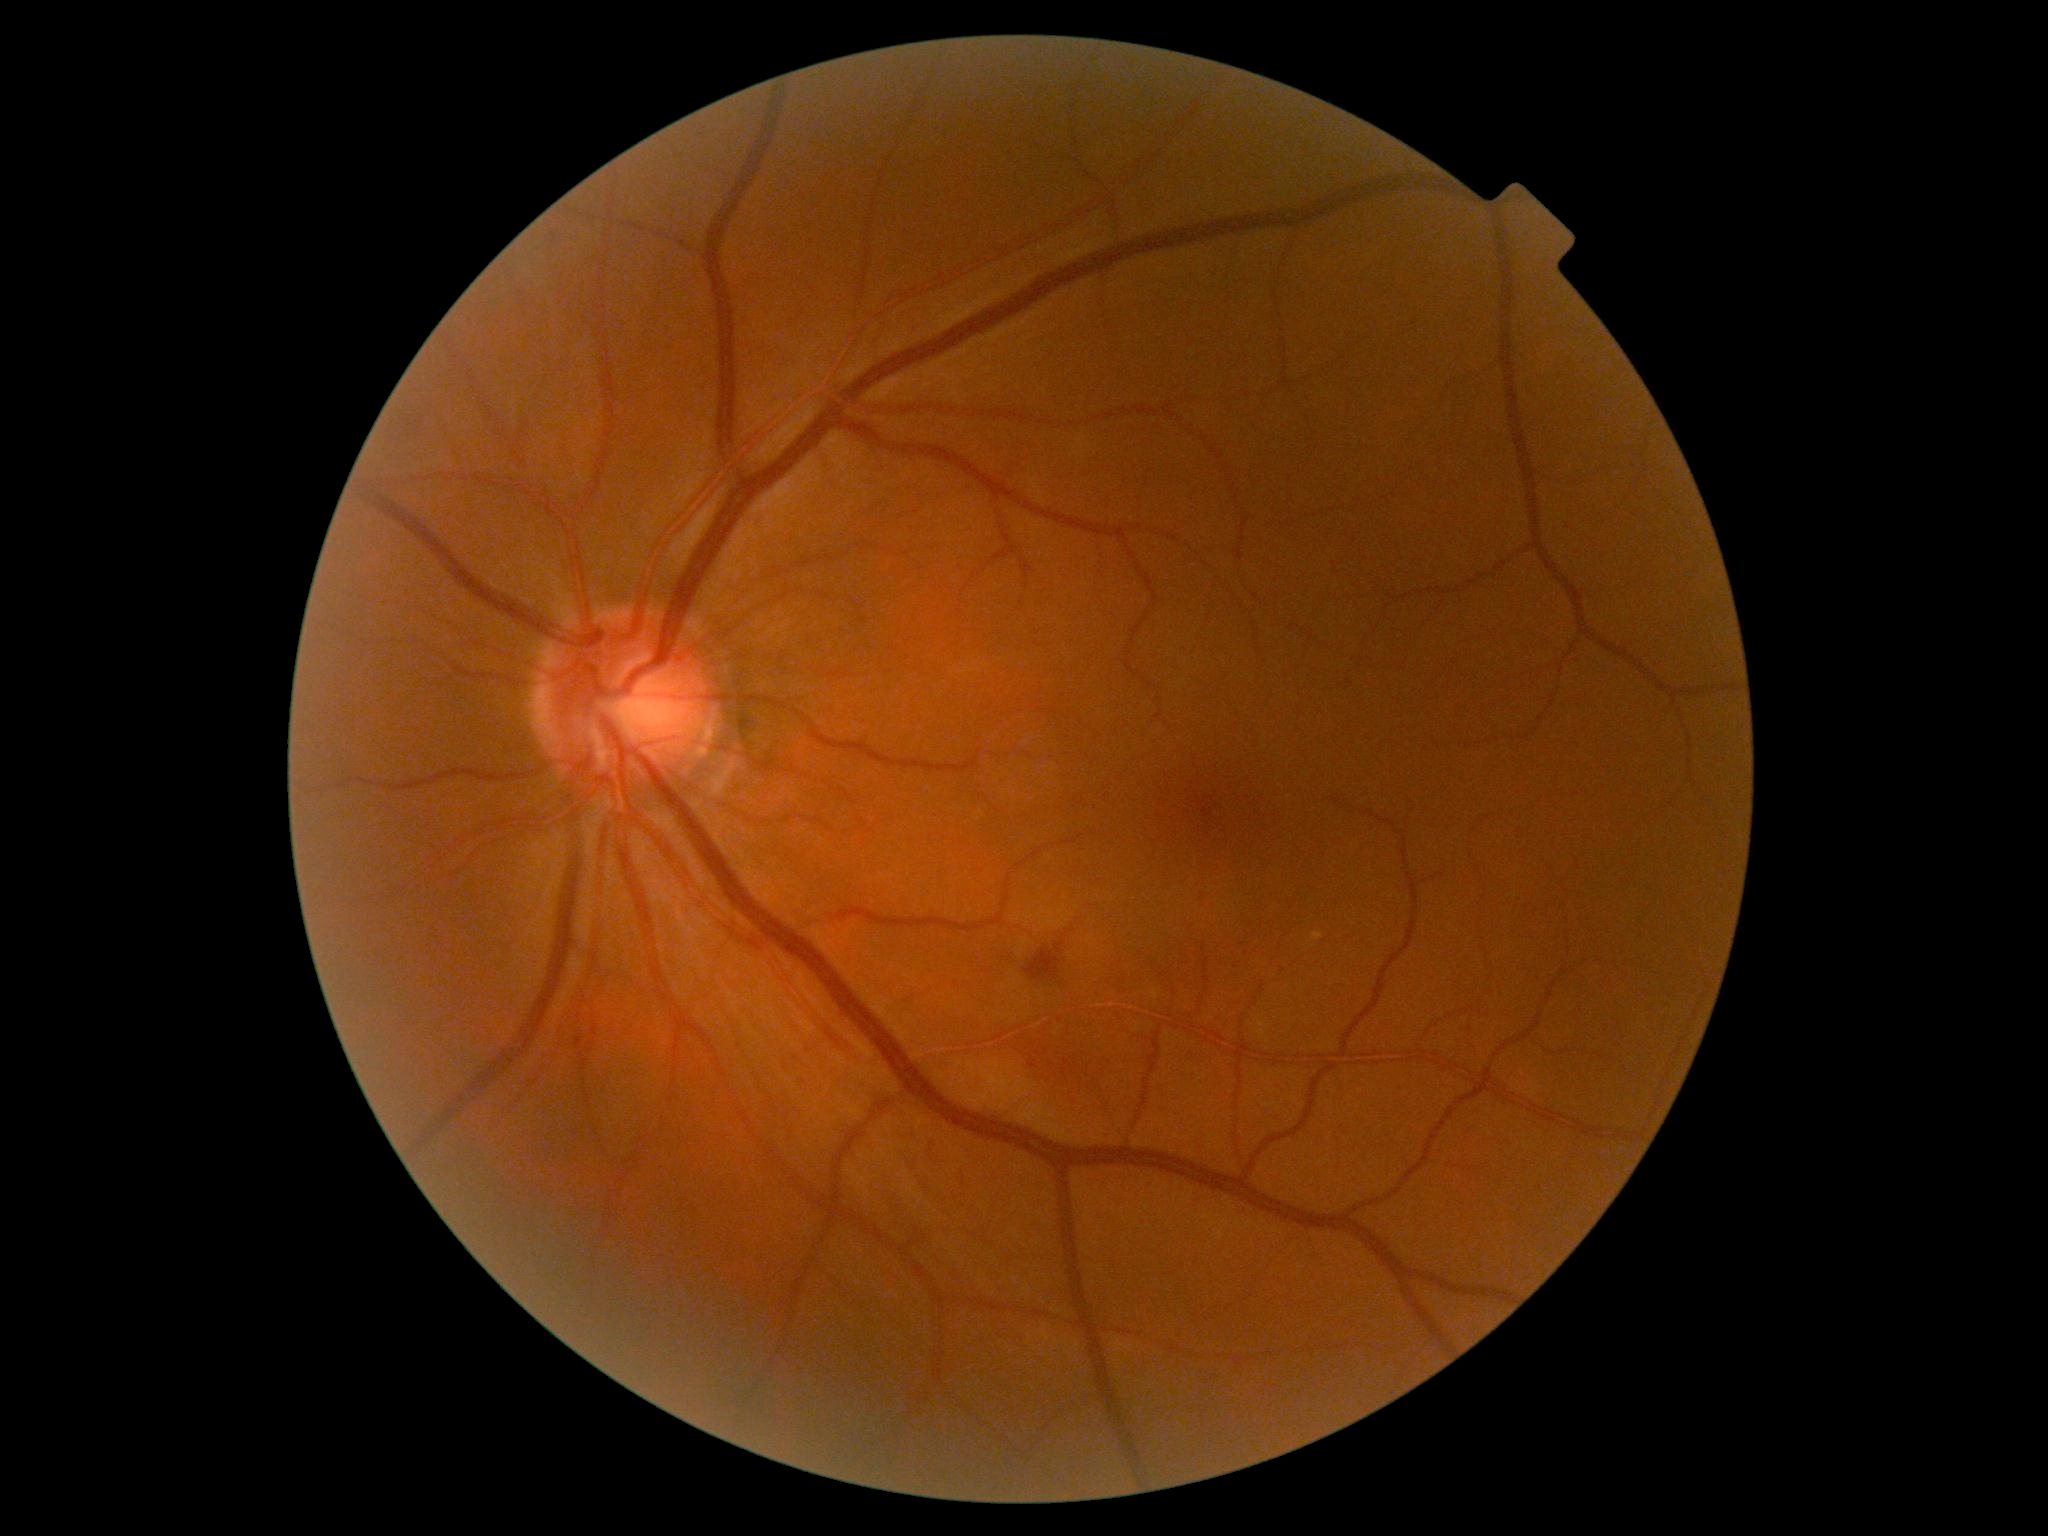 diabetic retinopathy (DR) = moderate NPDR (grade 2).